Nonmydriatic:
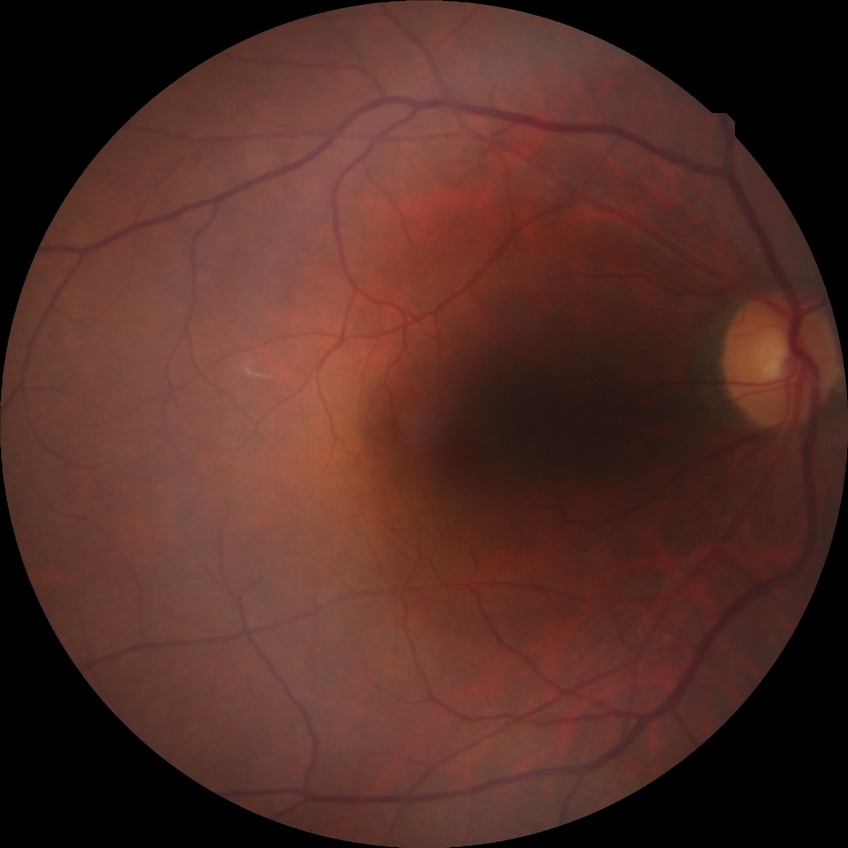

Diabetic retinopathy (DR): NDR (no diabetic retinopathy).